Wide-field fundus photograph from neonatal ROP screening:
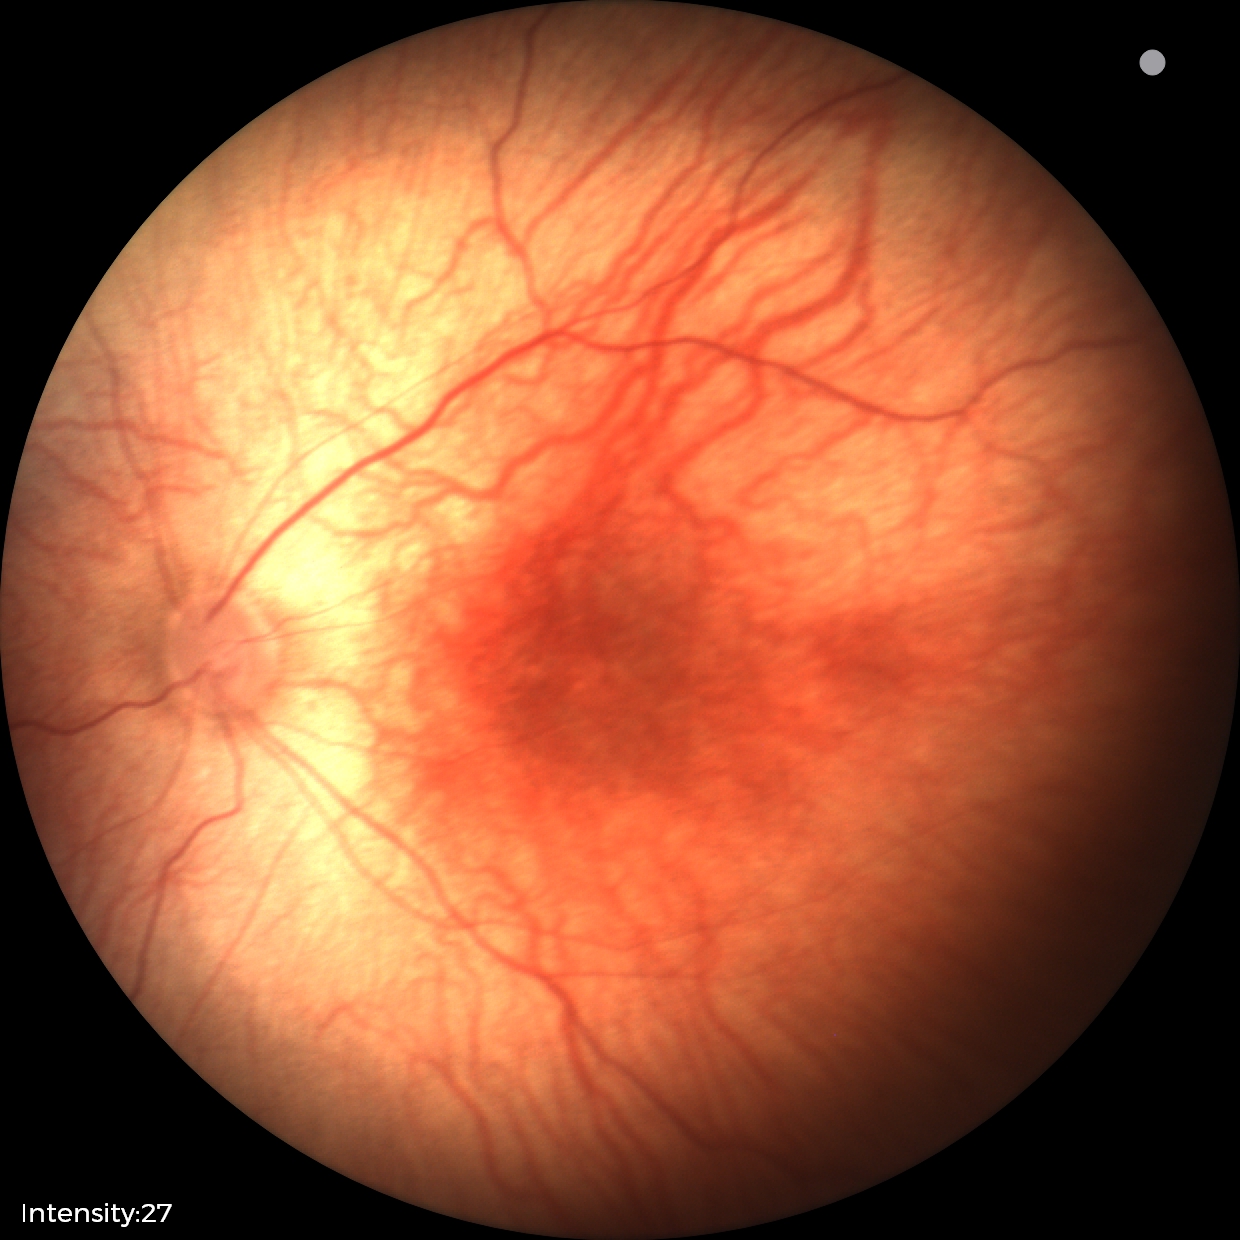 Screening examination with no abnormal retinal findings.